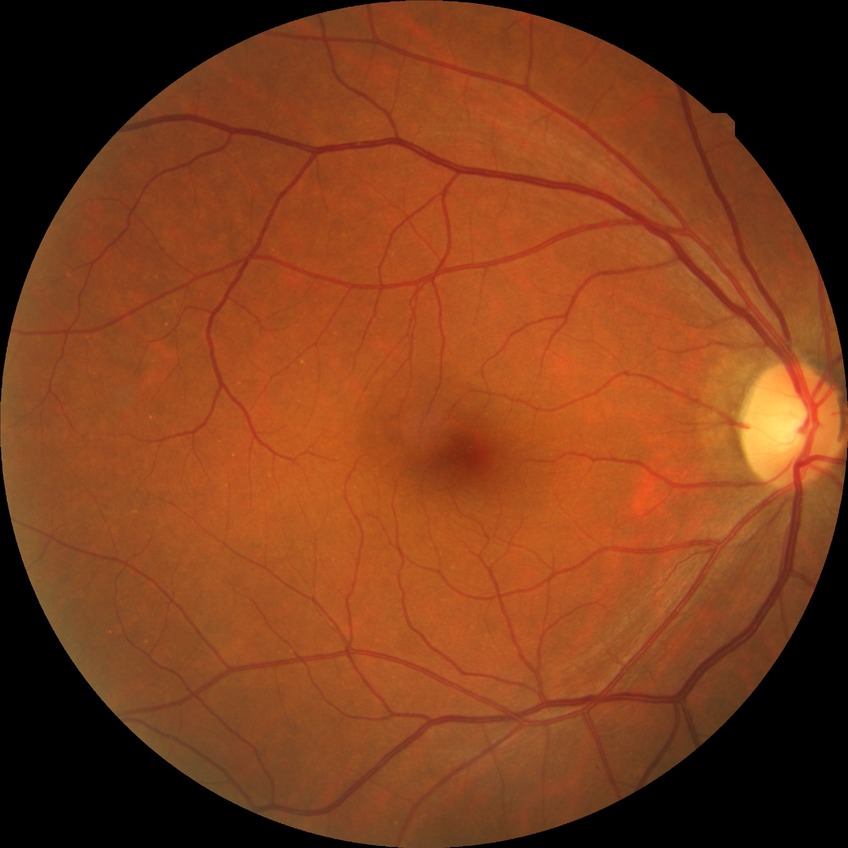 Davis grading is no diabetic retinopathy.